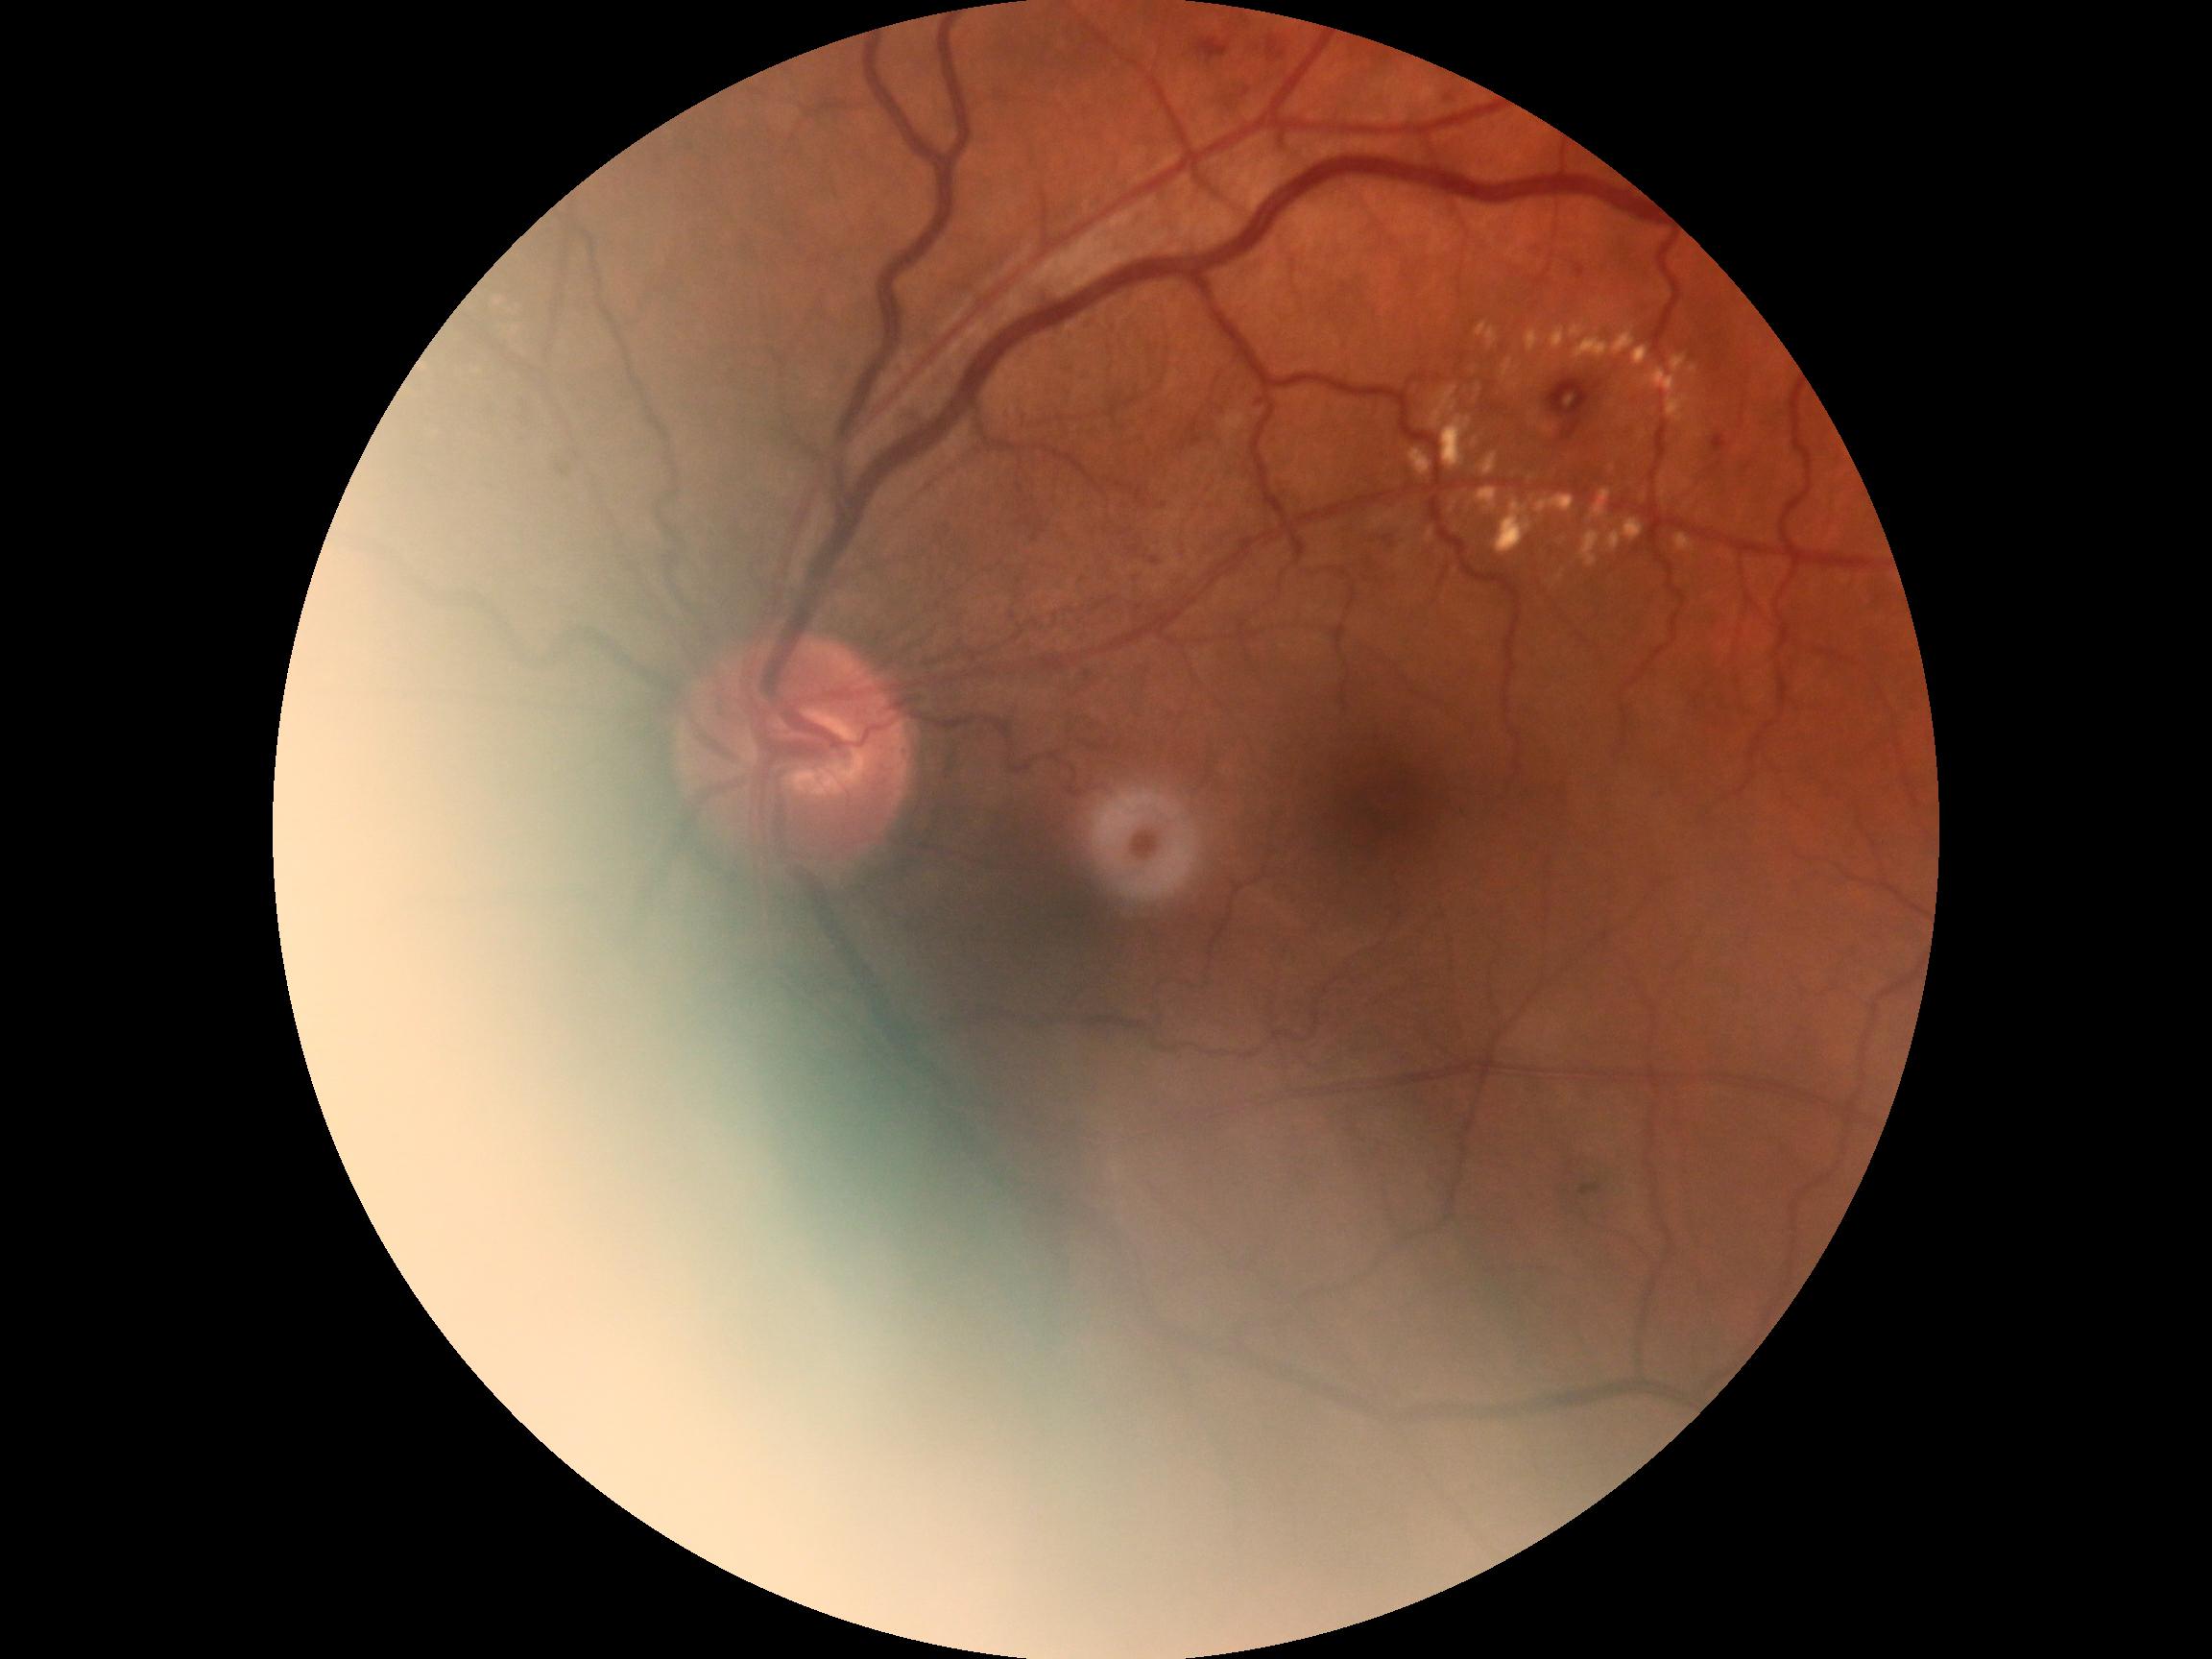

{"dr_category": "non-proliferative diabetic retinopathy", "dr_grade": "grade 2"}